Wide-field fundus photograph from neonatal ROP screening. Phoenix ICON, 100° FOV:
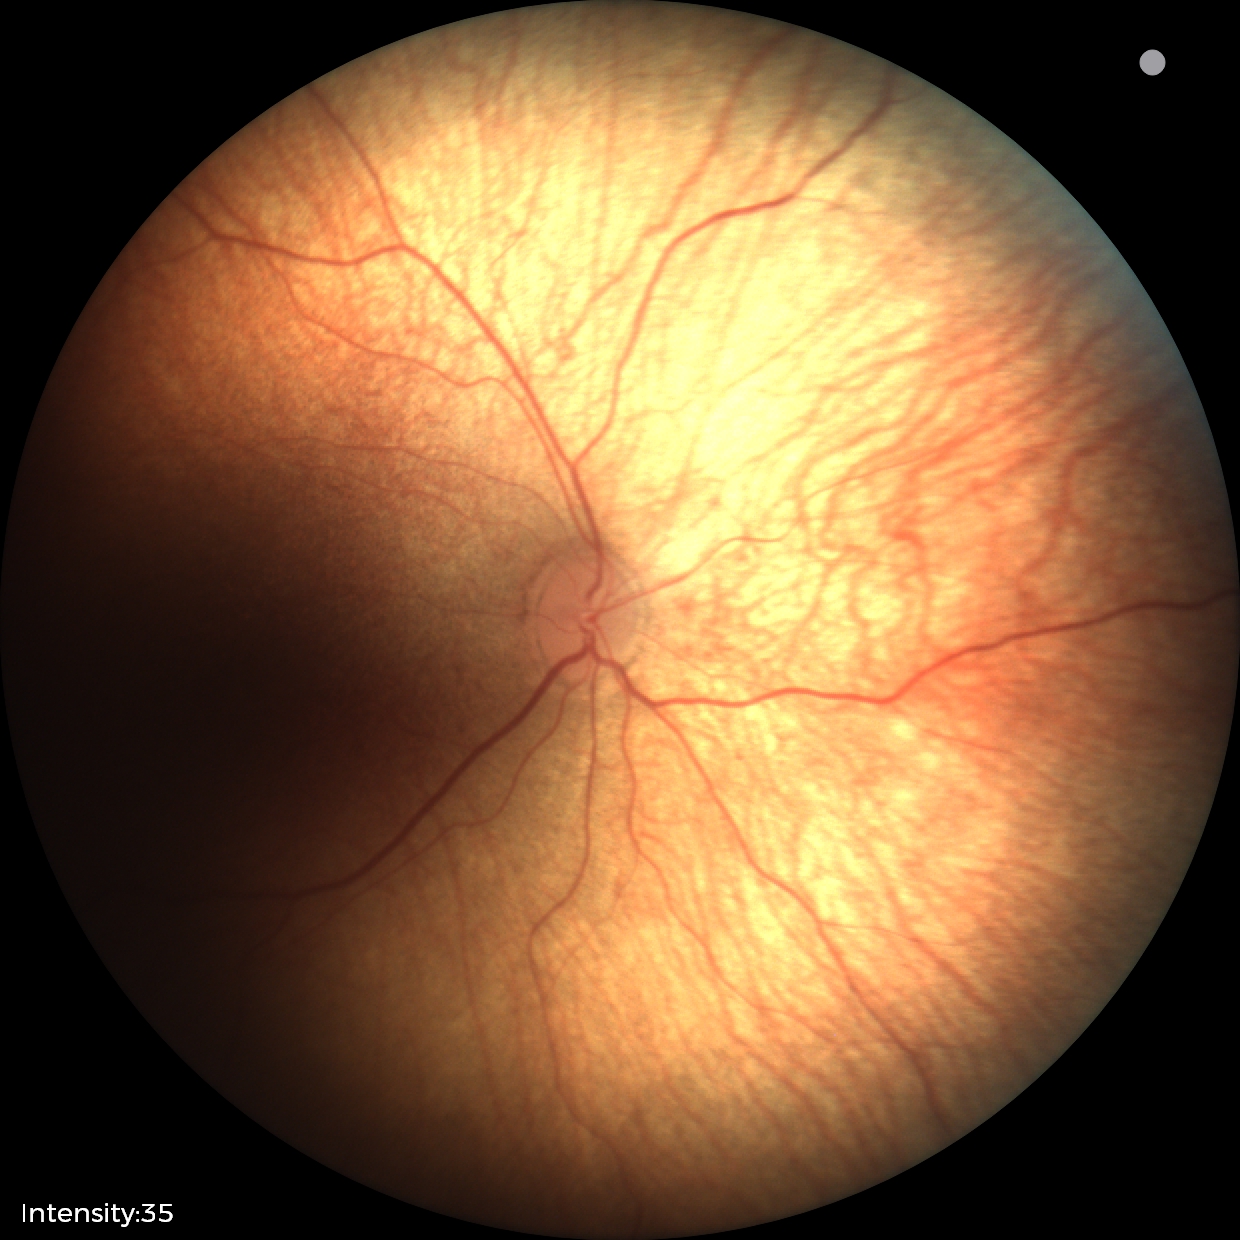

Assessment: normal fundus examination.